Captured on a Topcon TRC-50DX fundus camera · pupil-dilated: 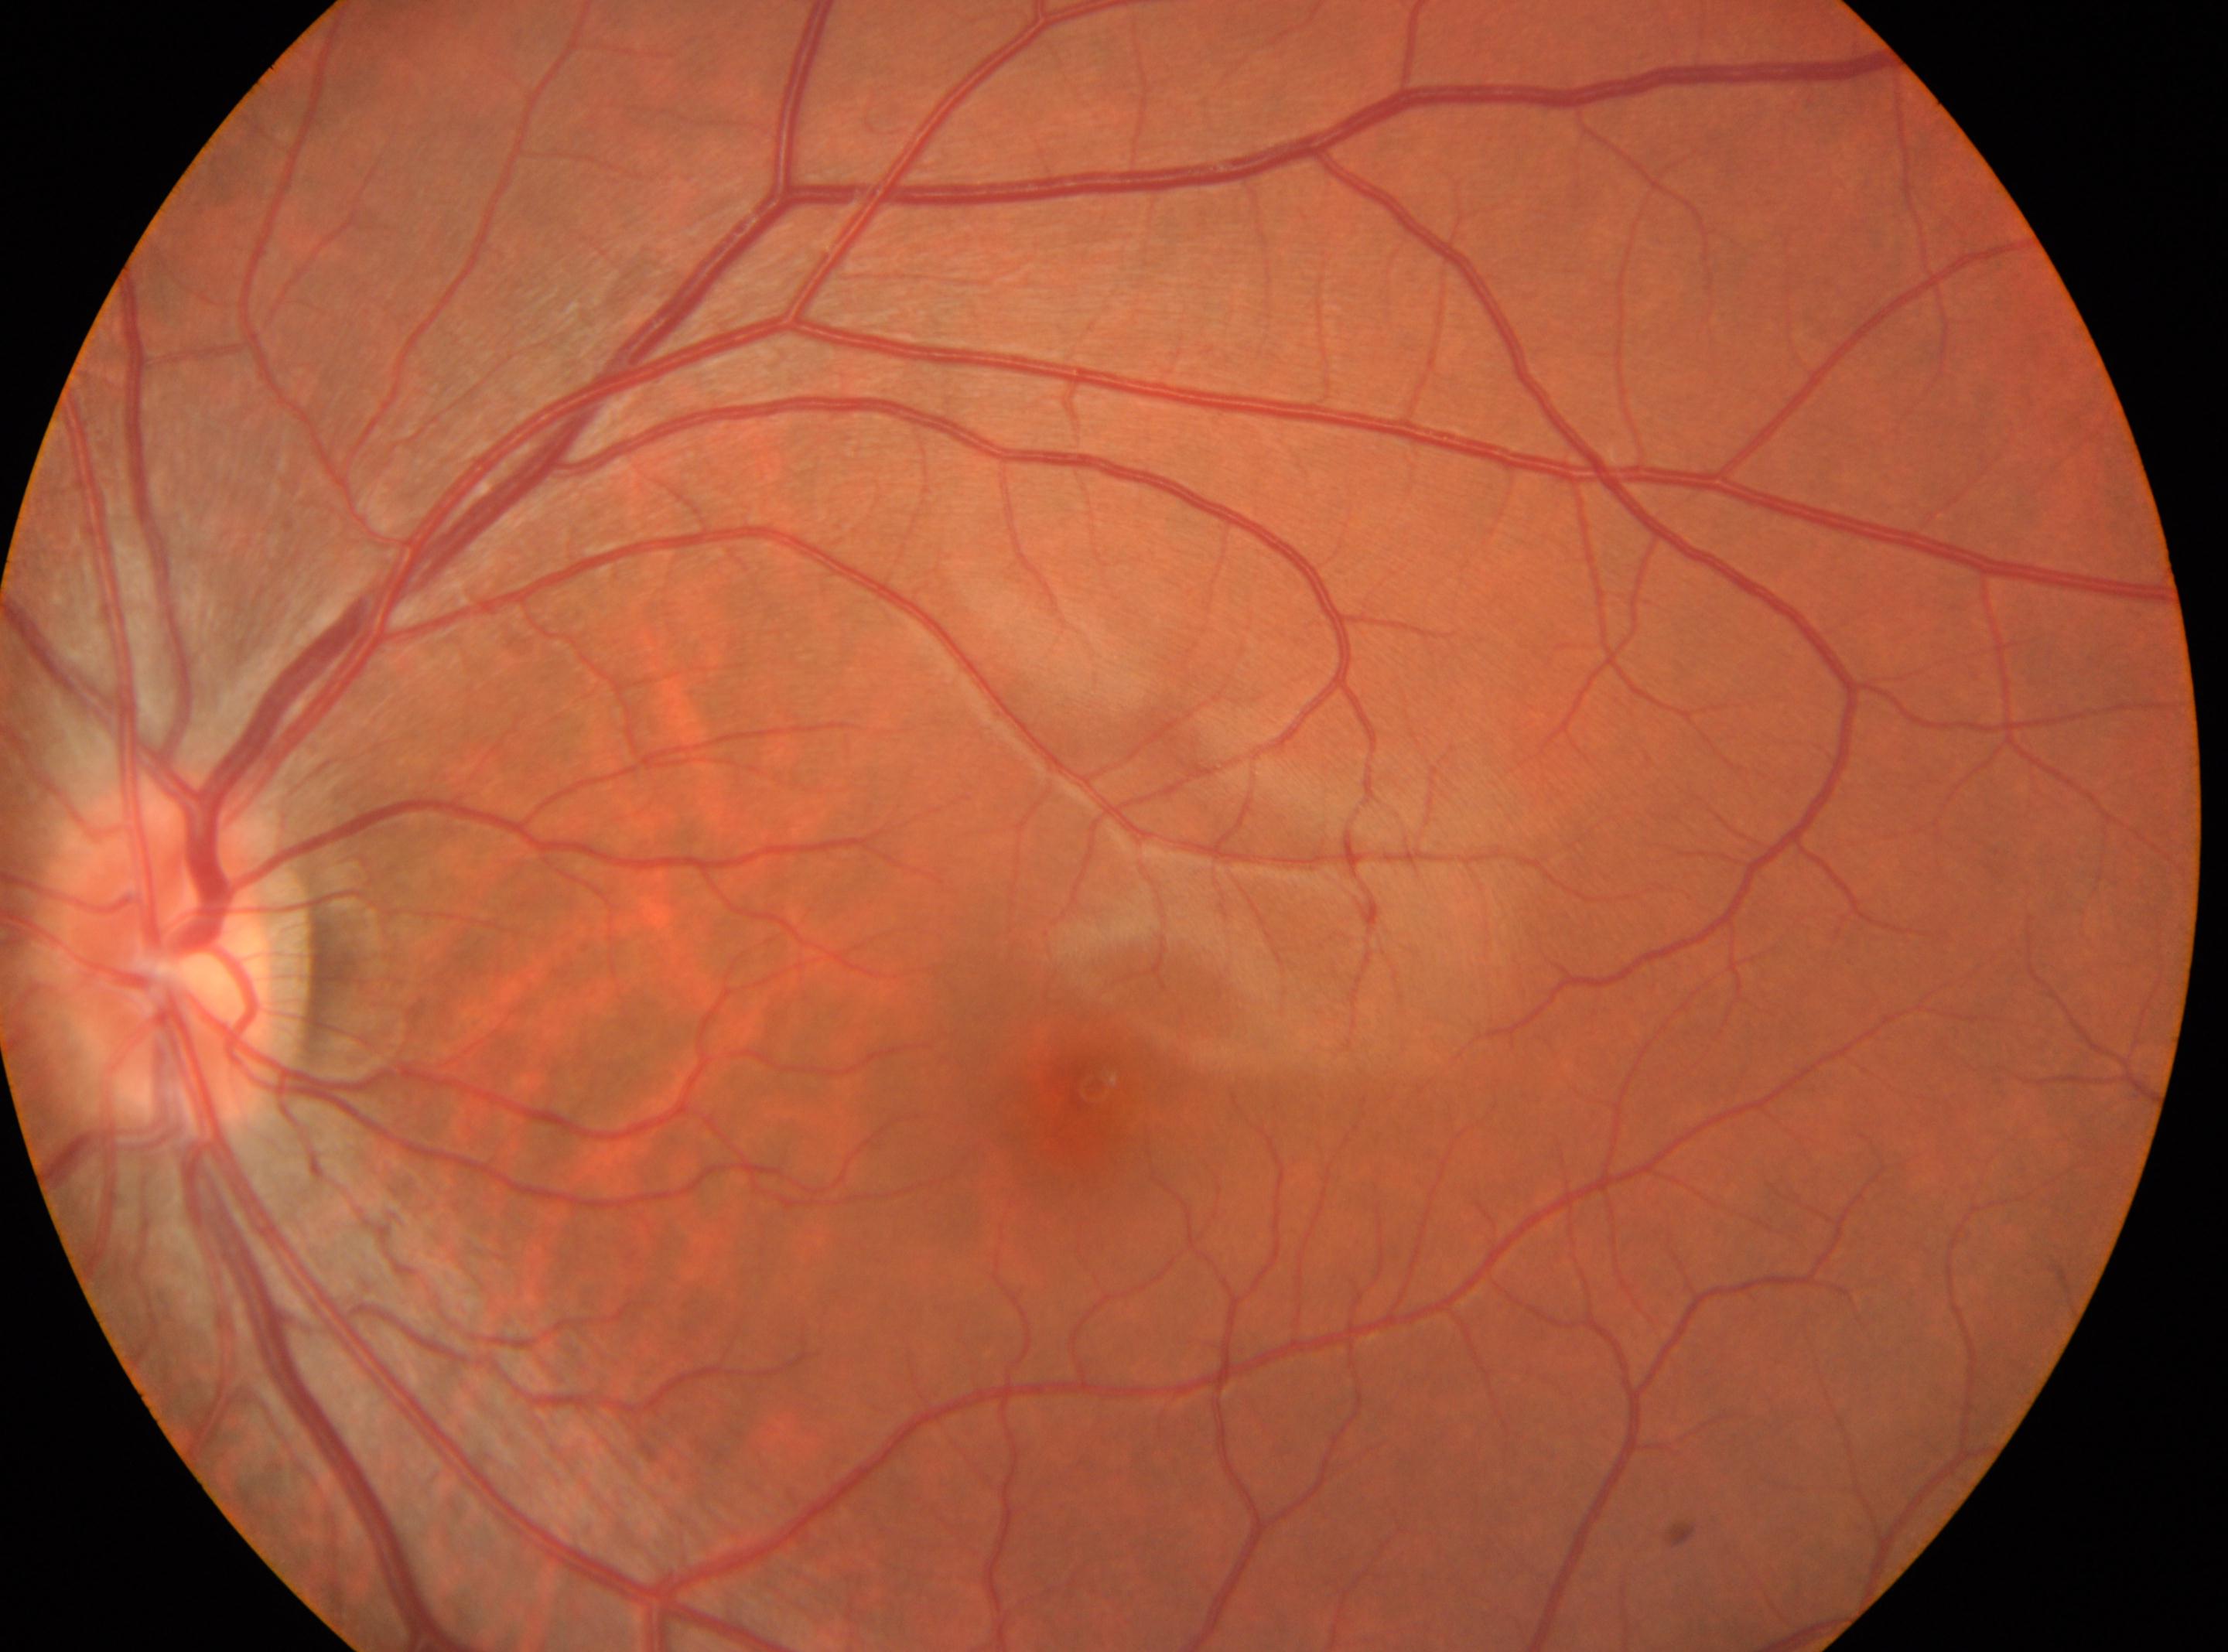 optic nerve head: (x: 168, y: 954), fovea center: (x: 1094, y: 1086), diabetic retinopathy (DR): grade 0 (no apparent retinopathy), laterality: the left eye.